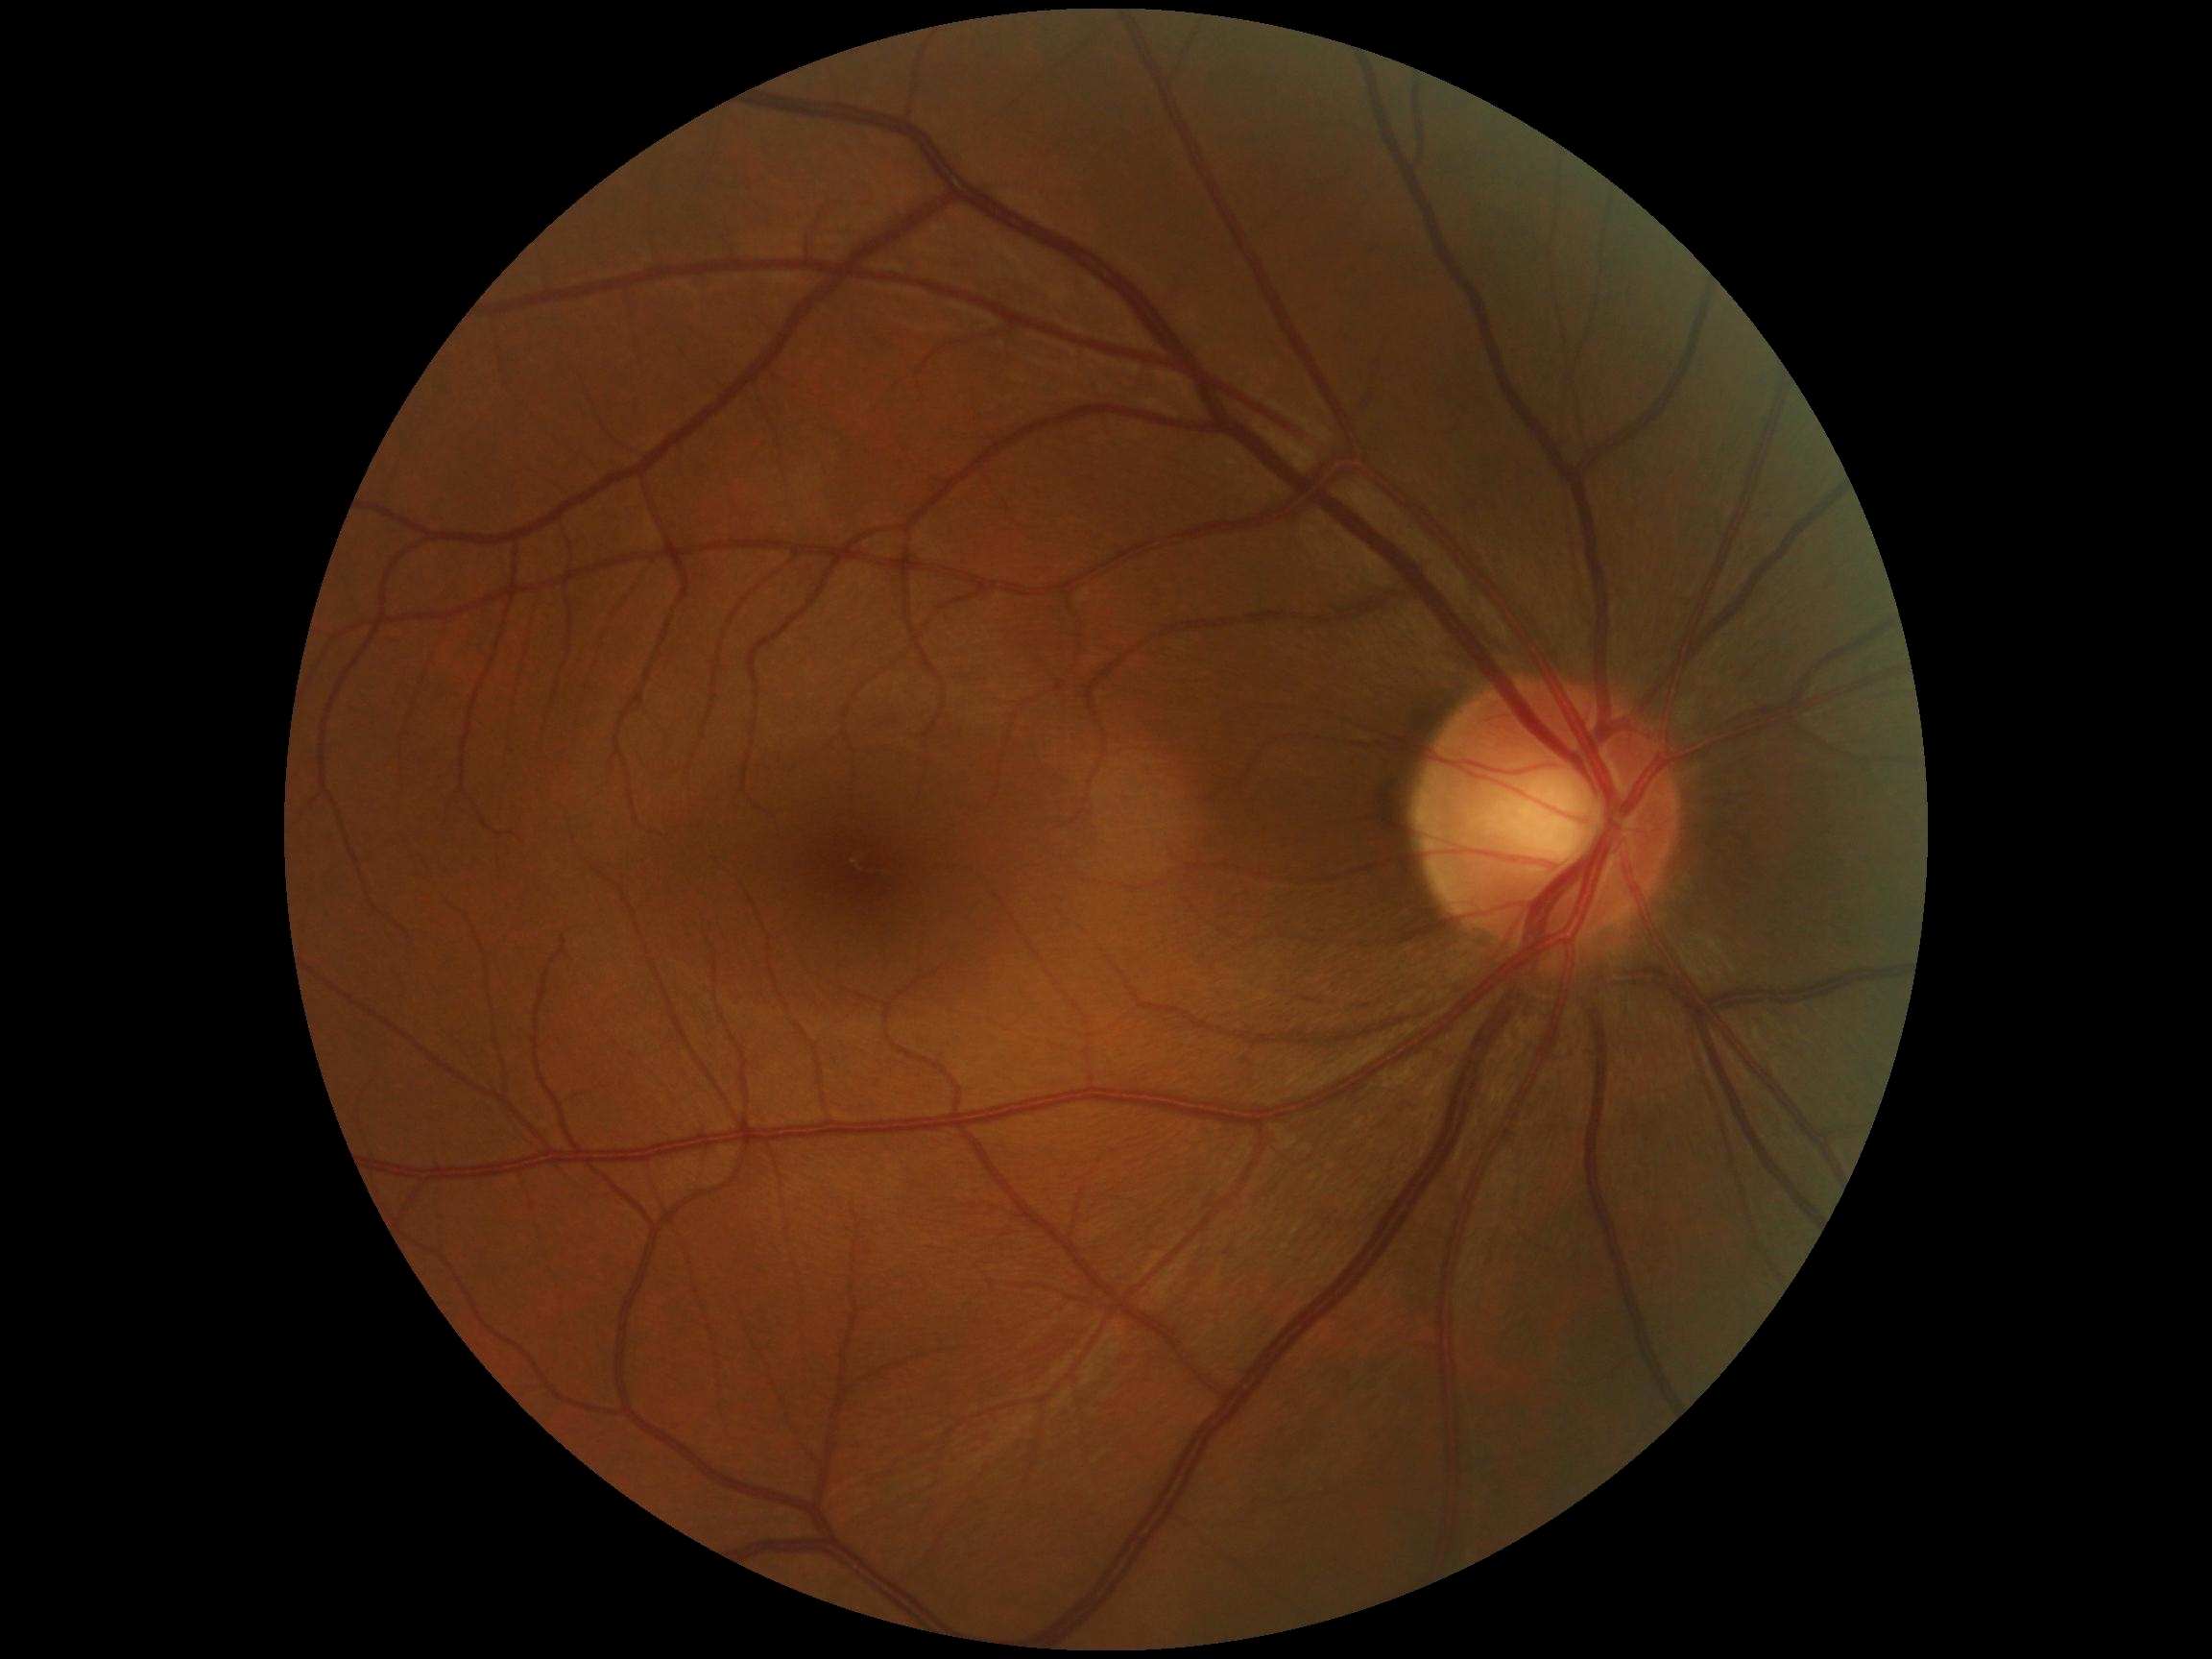

DR impression: no apparent DR
DR severity: no apparent diabetic retinopathy (grade 0)